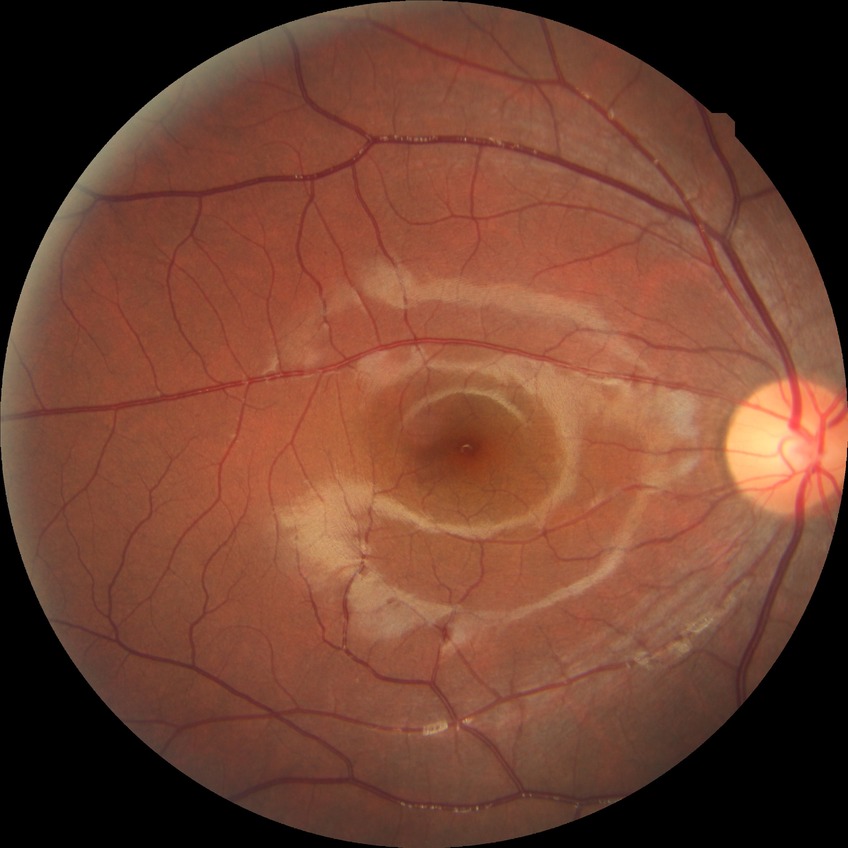
Diabetic retinopathy (DR) is NDR (no diabetic retinopathy).